Wide-field fundus image from infant ROP screening. Phoenix ICON, 100° FOV: 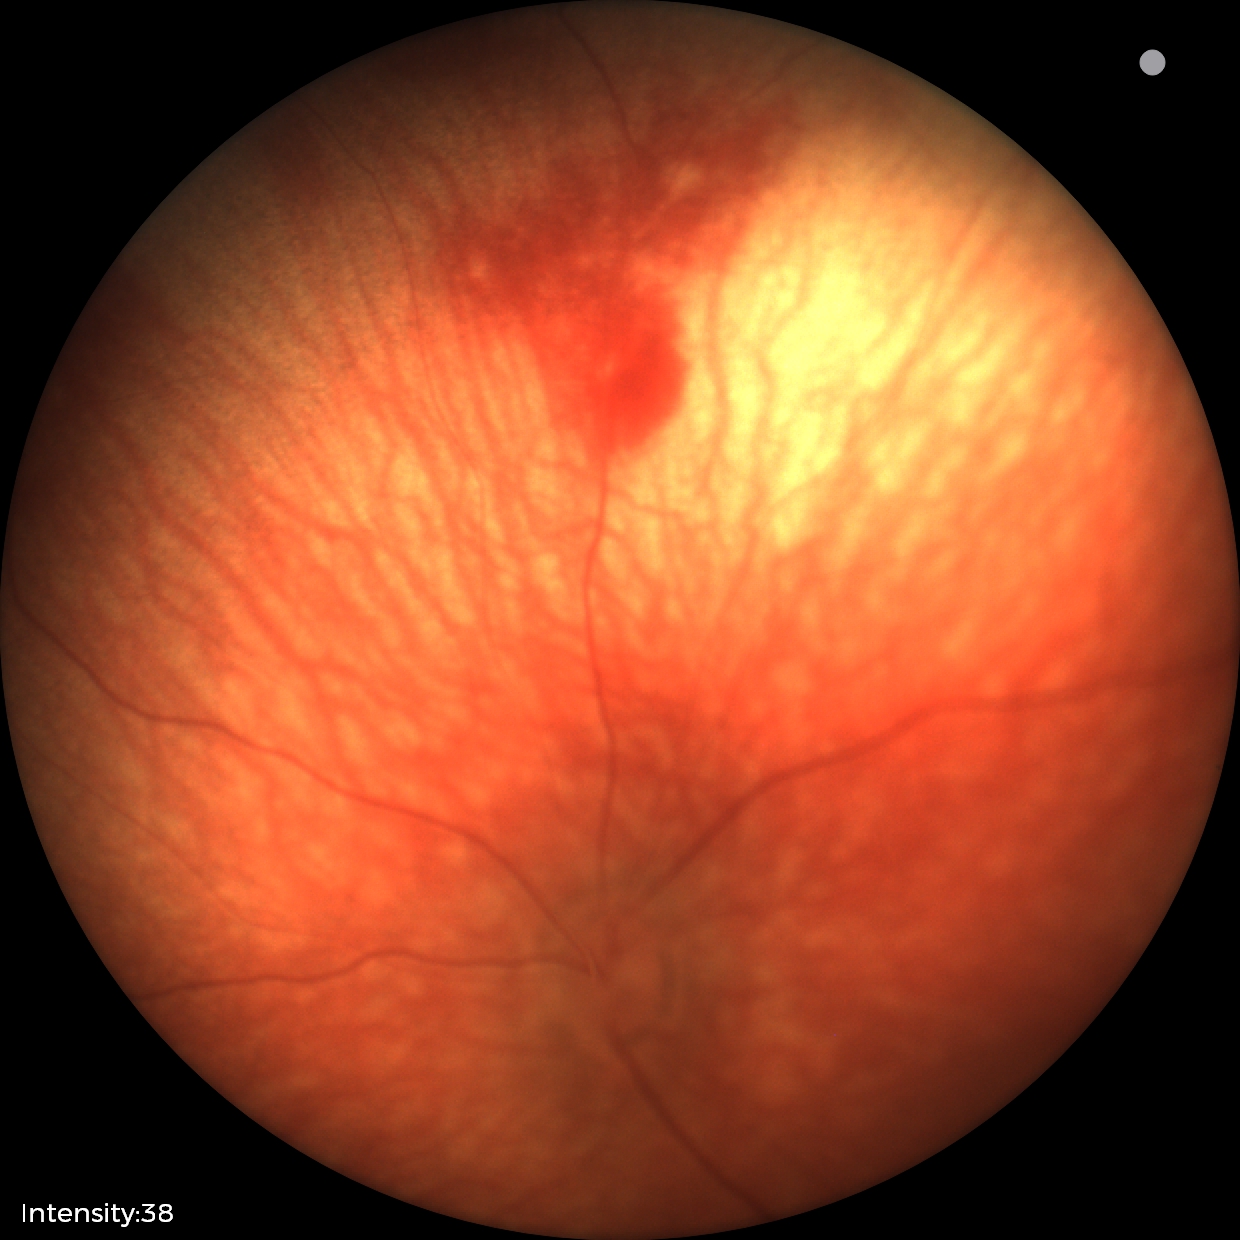 Q: What was the screening finding?
A: retinal hemorrhages